Portable fundus photograph: 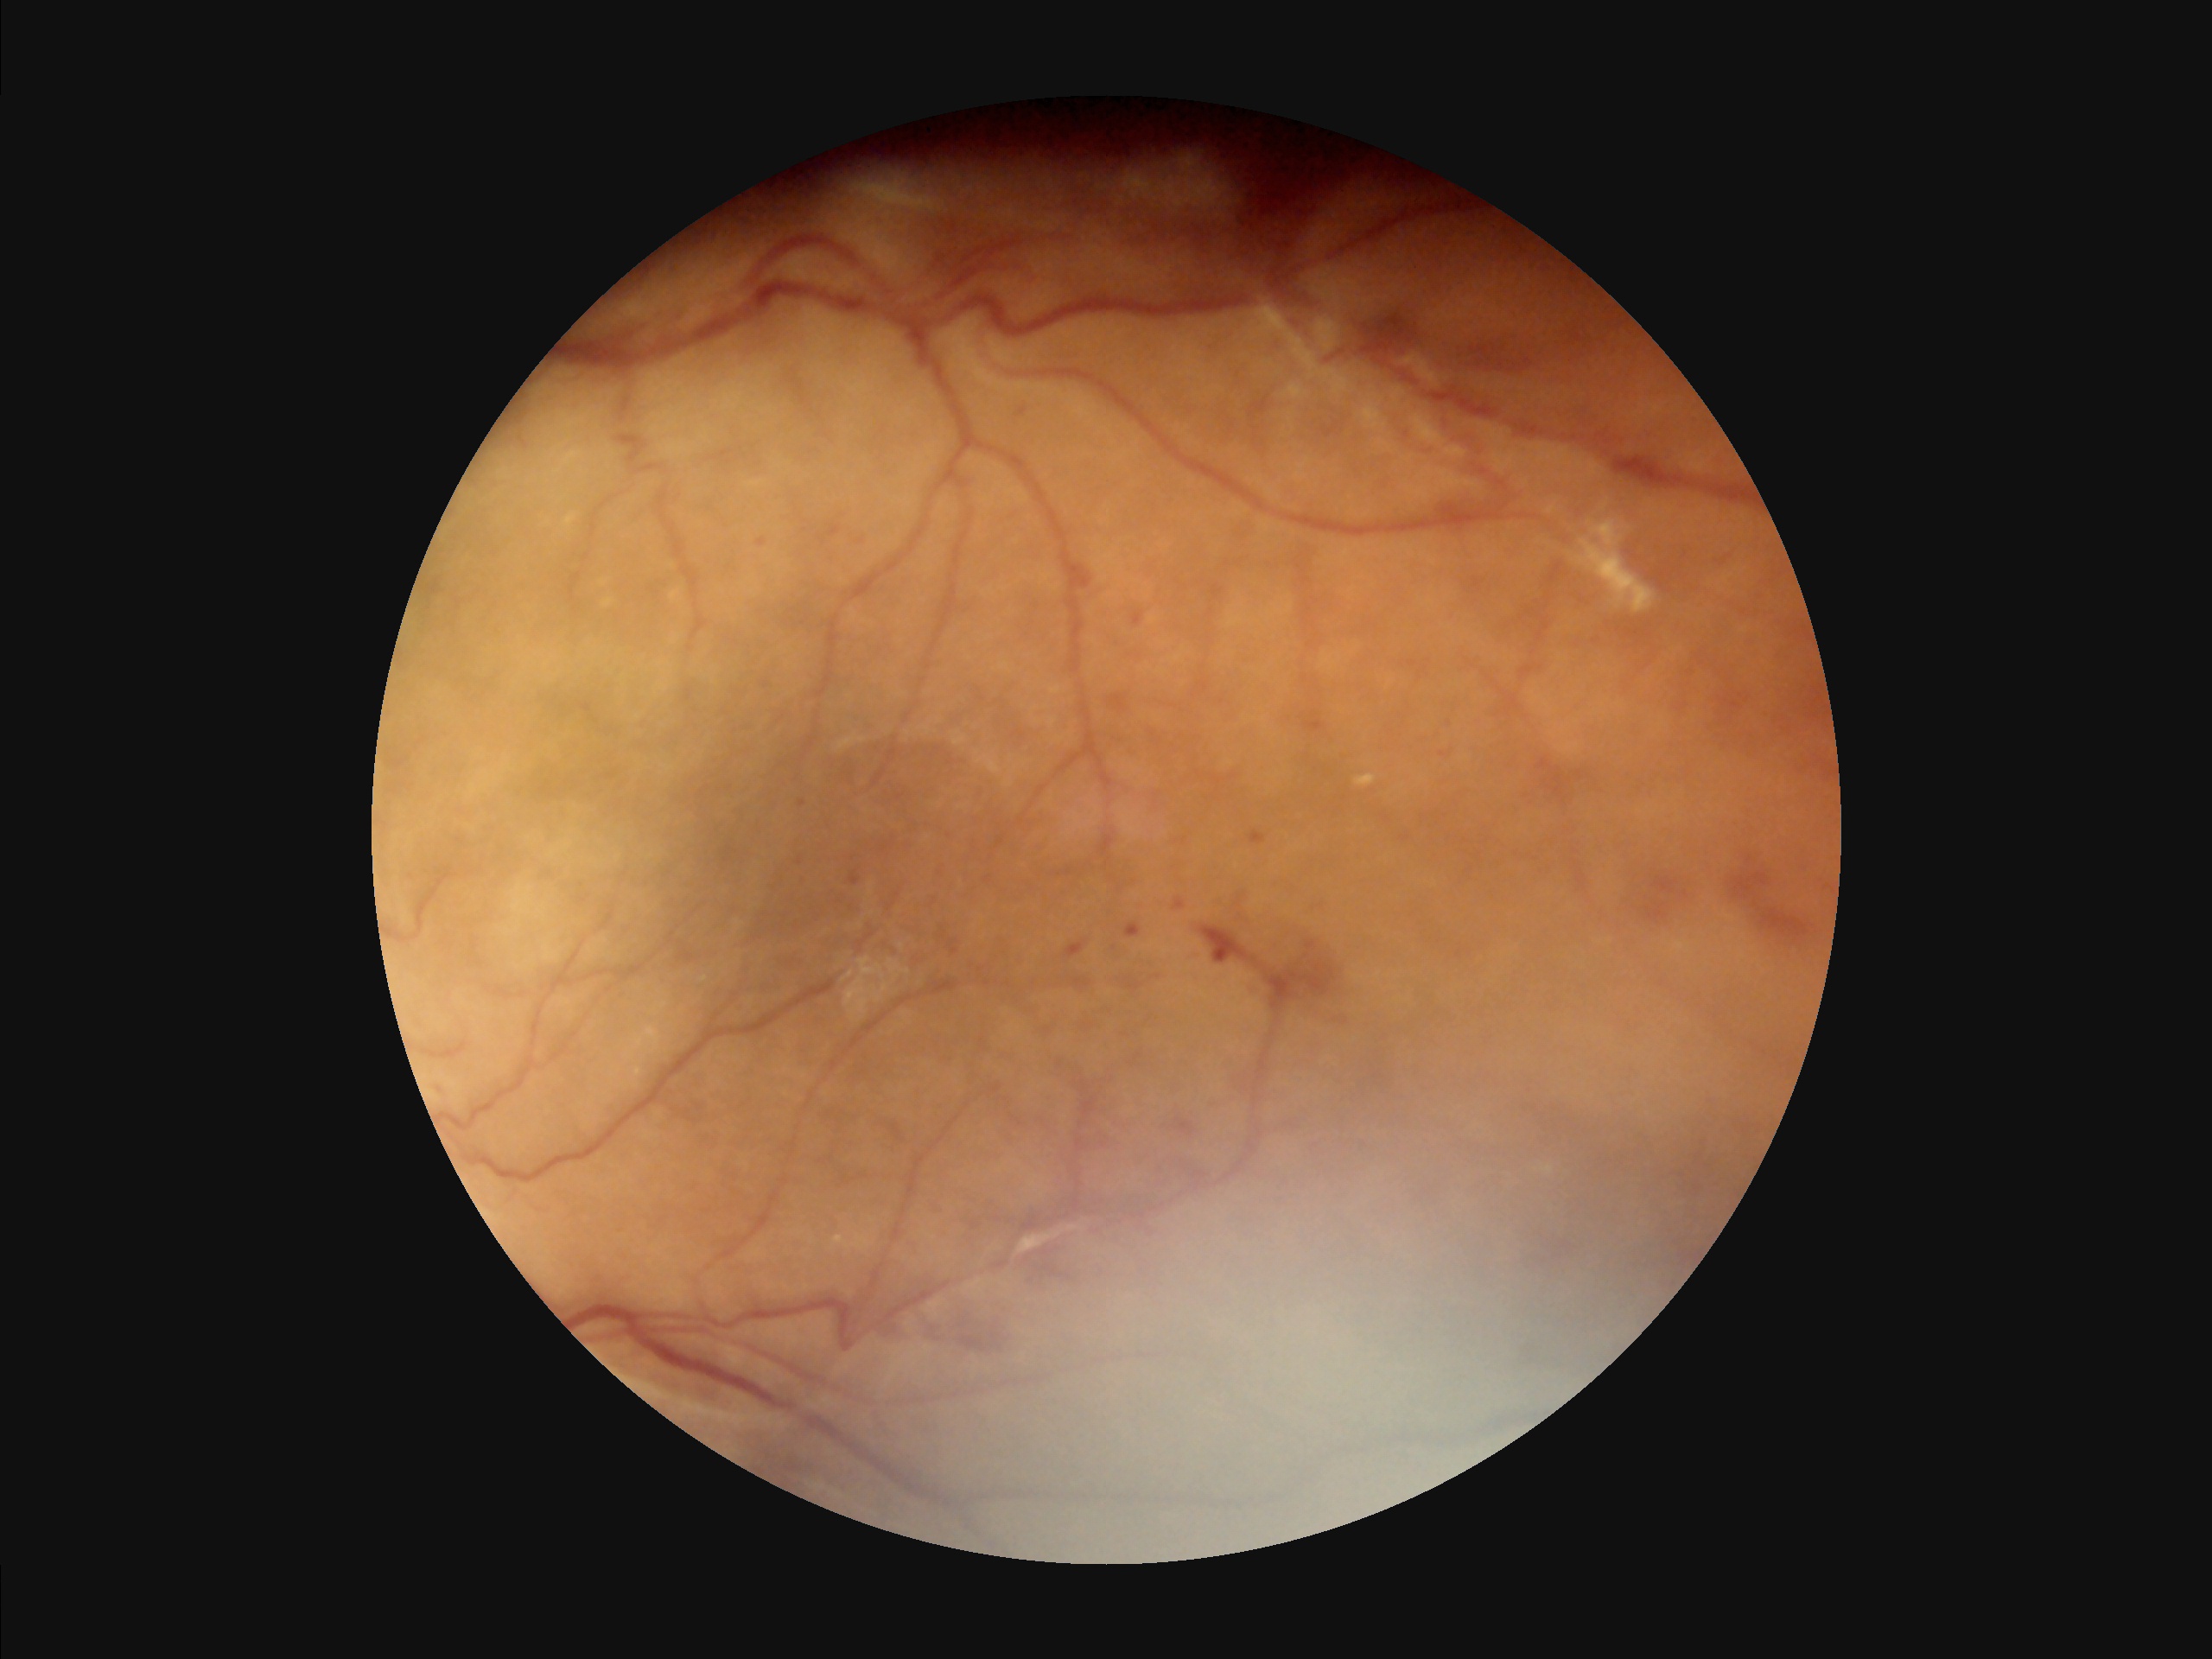
Image quality assessment: overall: adequate; illumination: satisfactory; contrast: satisfactory; focus: blurry.